Acquired with a Topcon TRC-50DX. Pupil-dilated. Image size 2228x1652. Retinal fundus photograph: 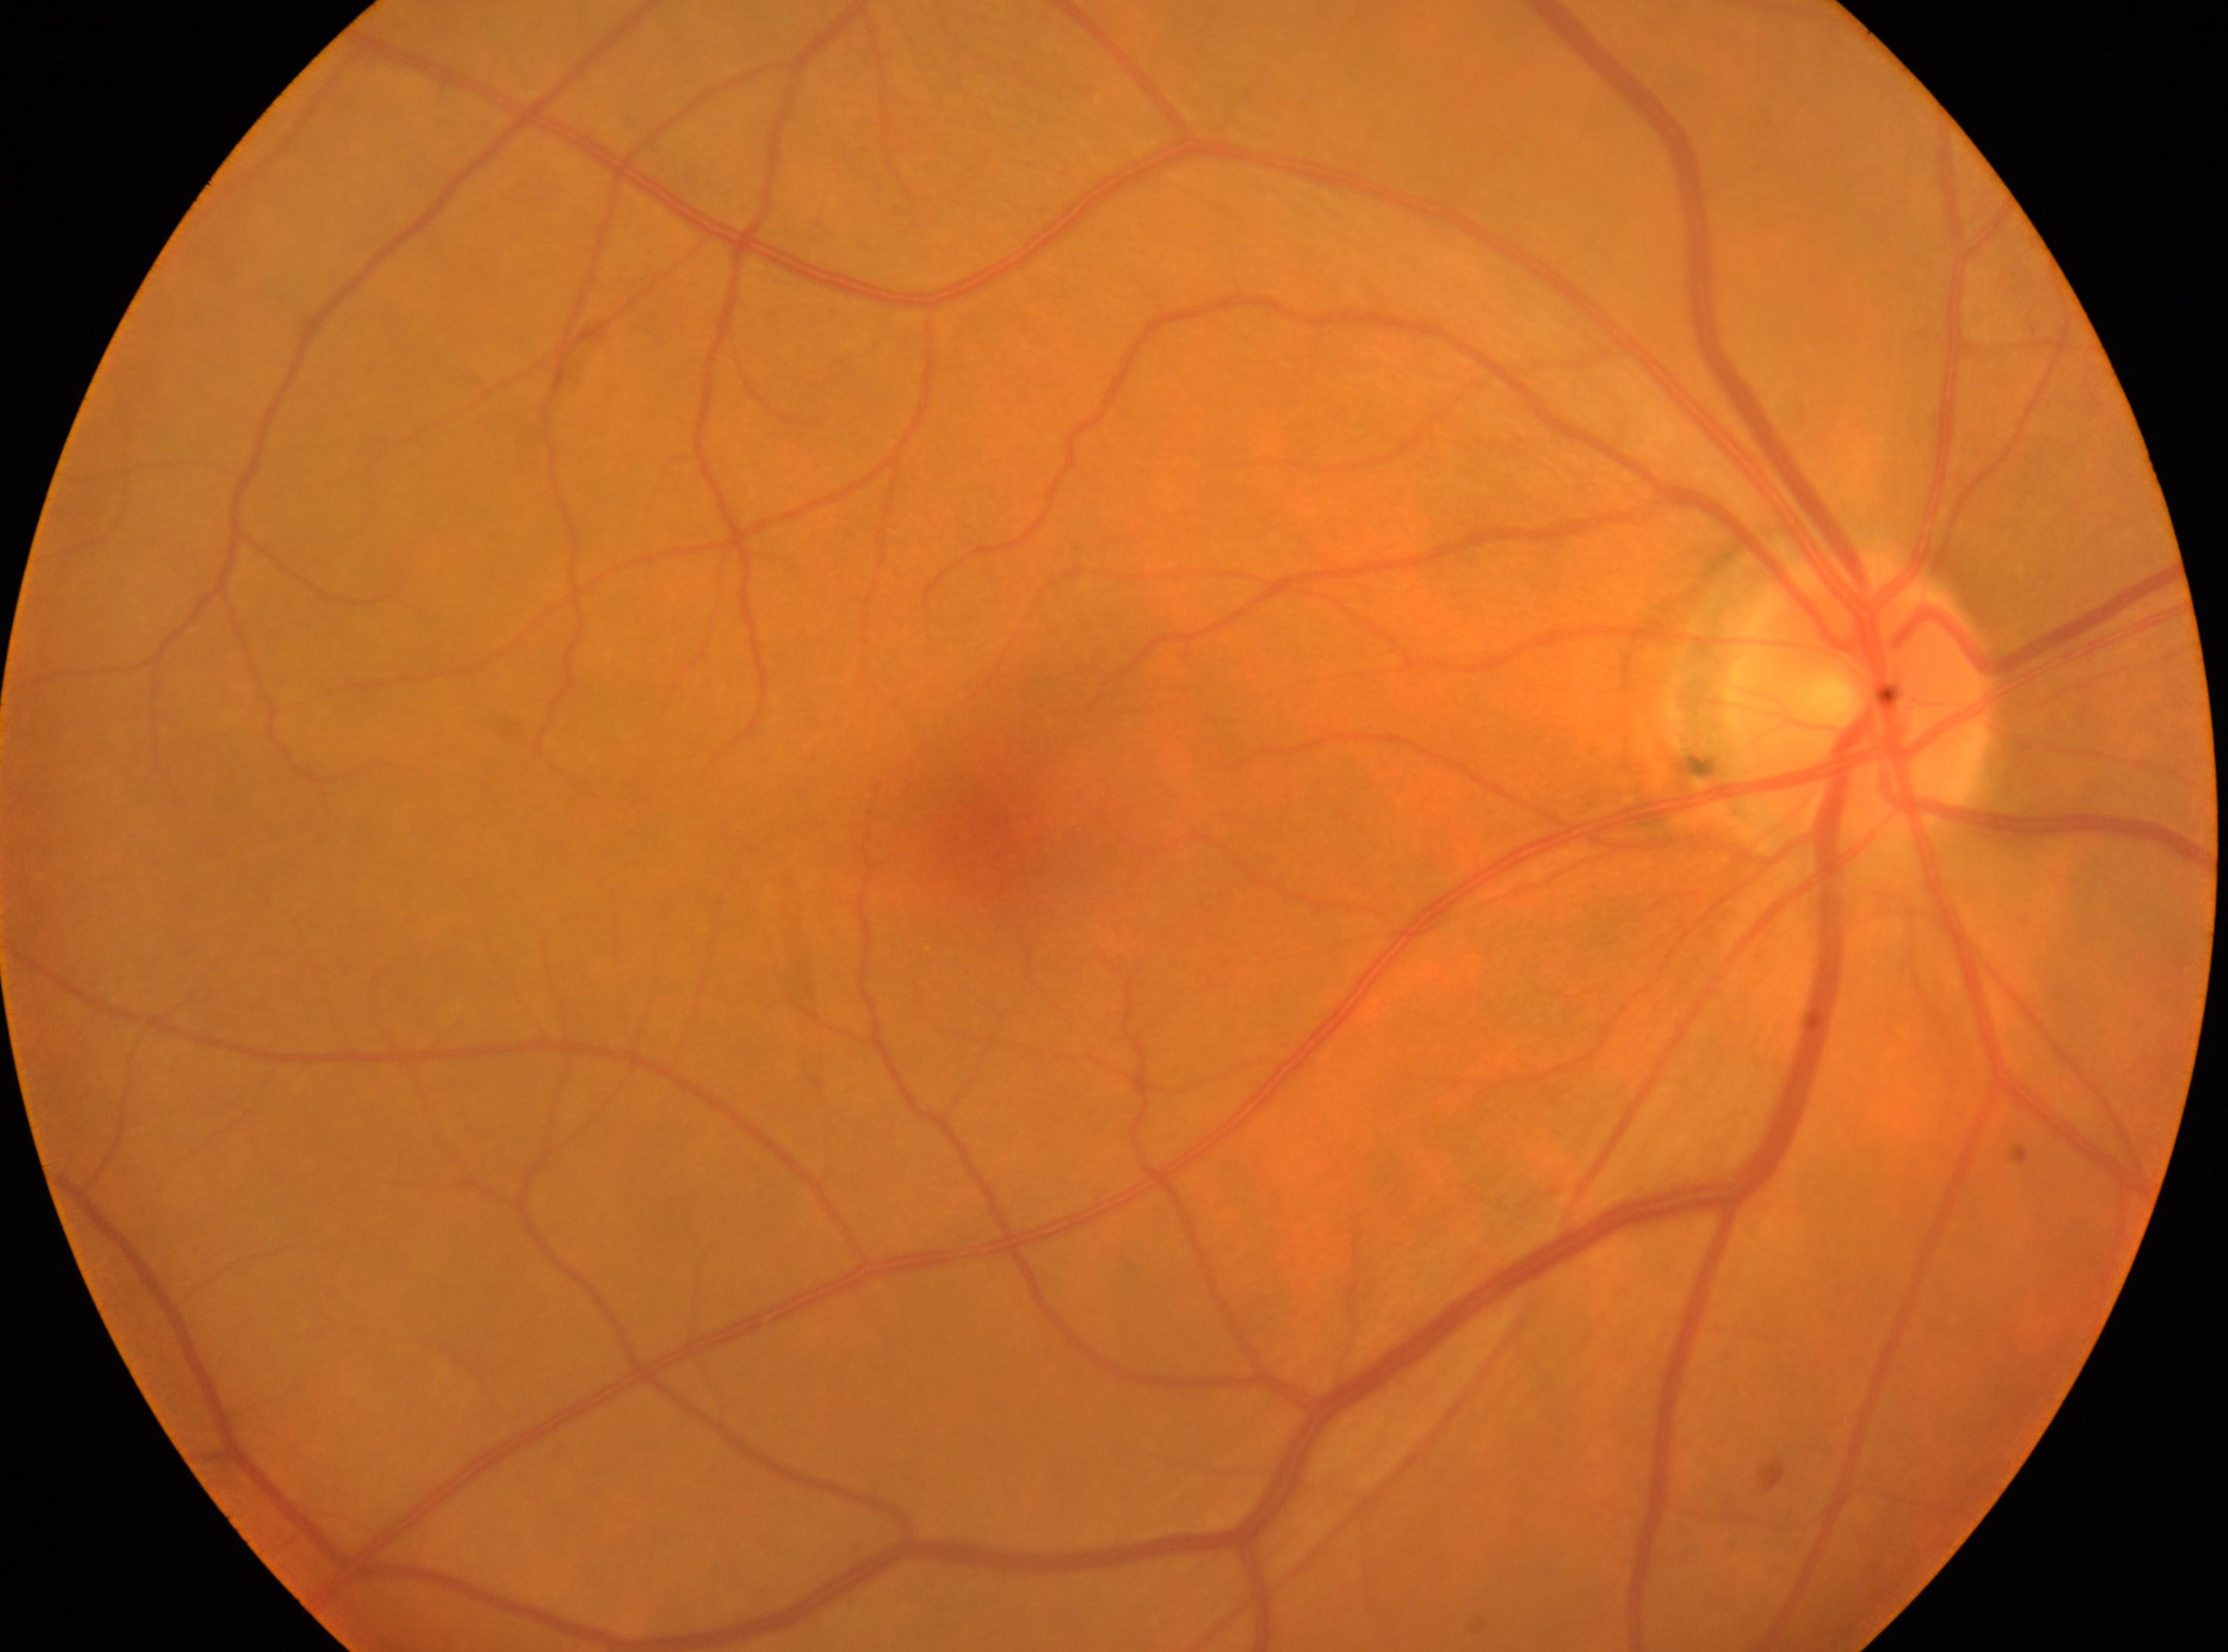

{"eye": "right", "fovea": "986px, 840px", "dr_grade": "no apparent retinopathy (grade 0)", "optic_disc": "1860px, 695px"}